NIDEK AFC-230
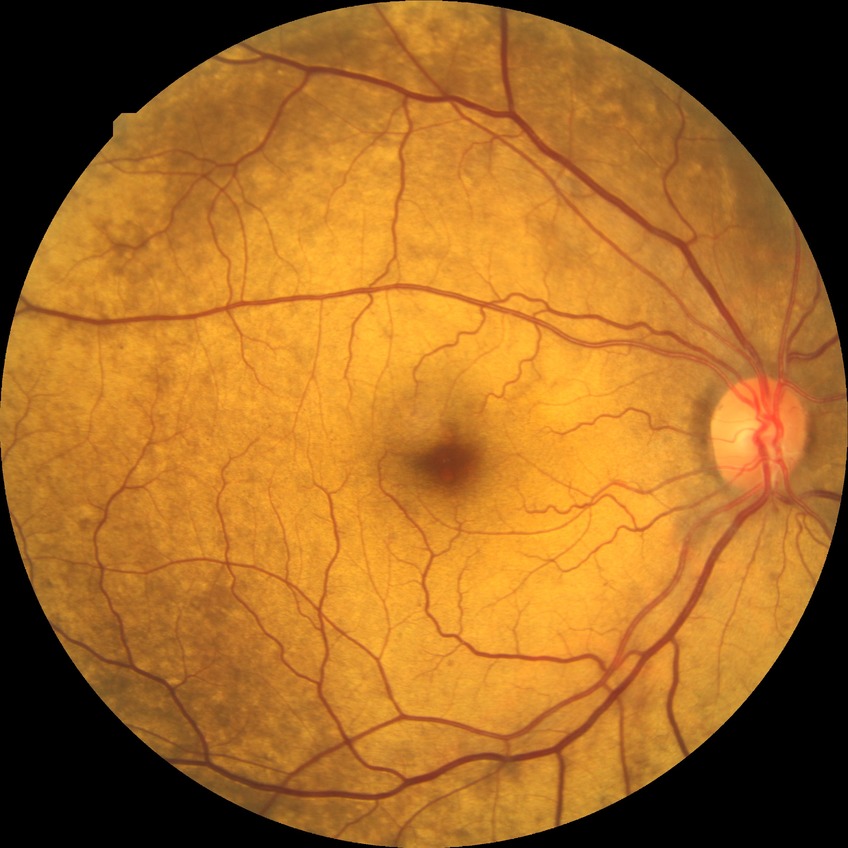 diabetic retinopathy (DR) = SDR (simple diabetic retinopathy)